Retinal fundus photograph, FOV: 45 degrees — 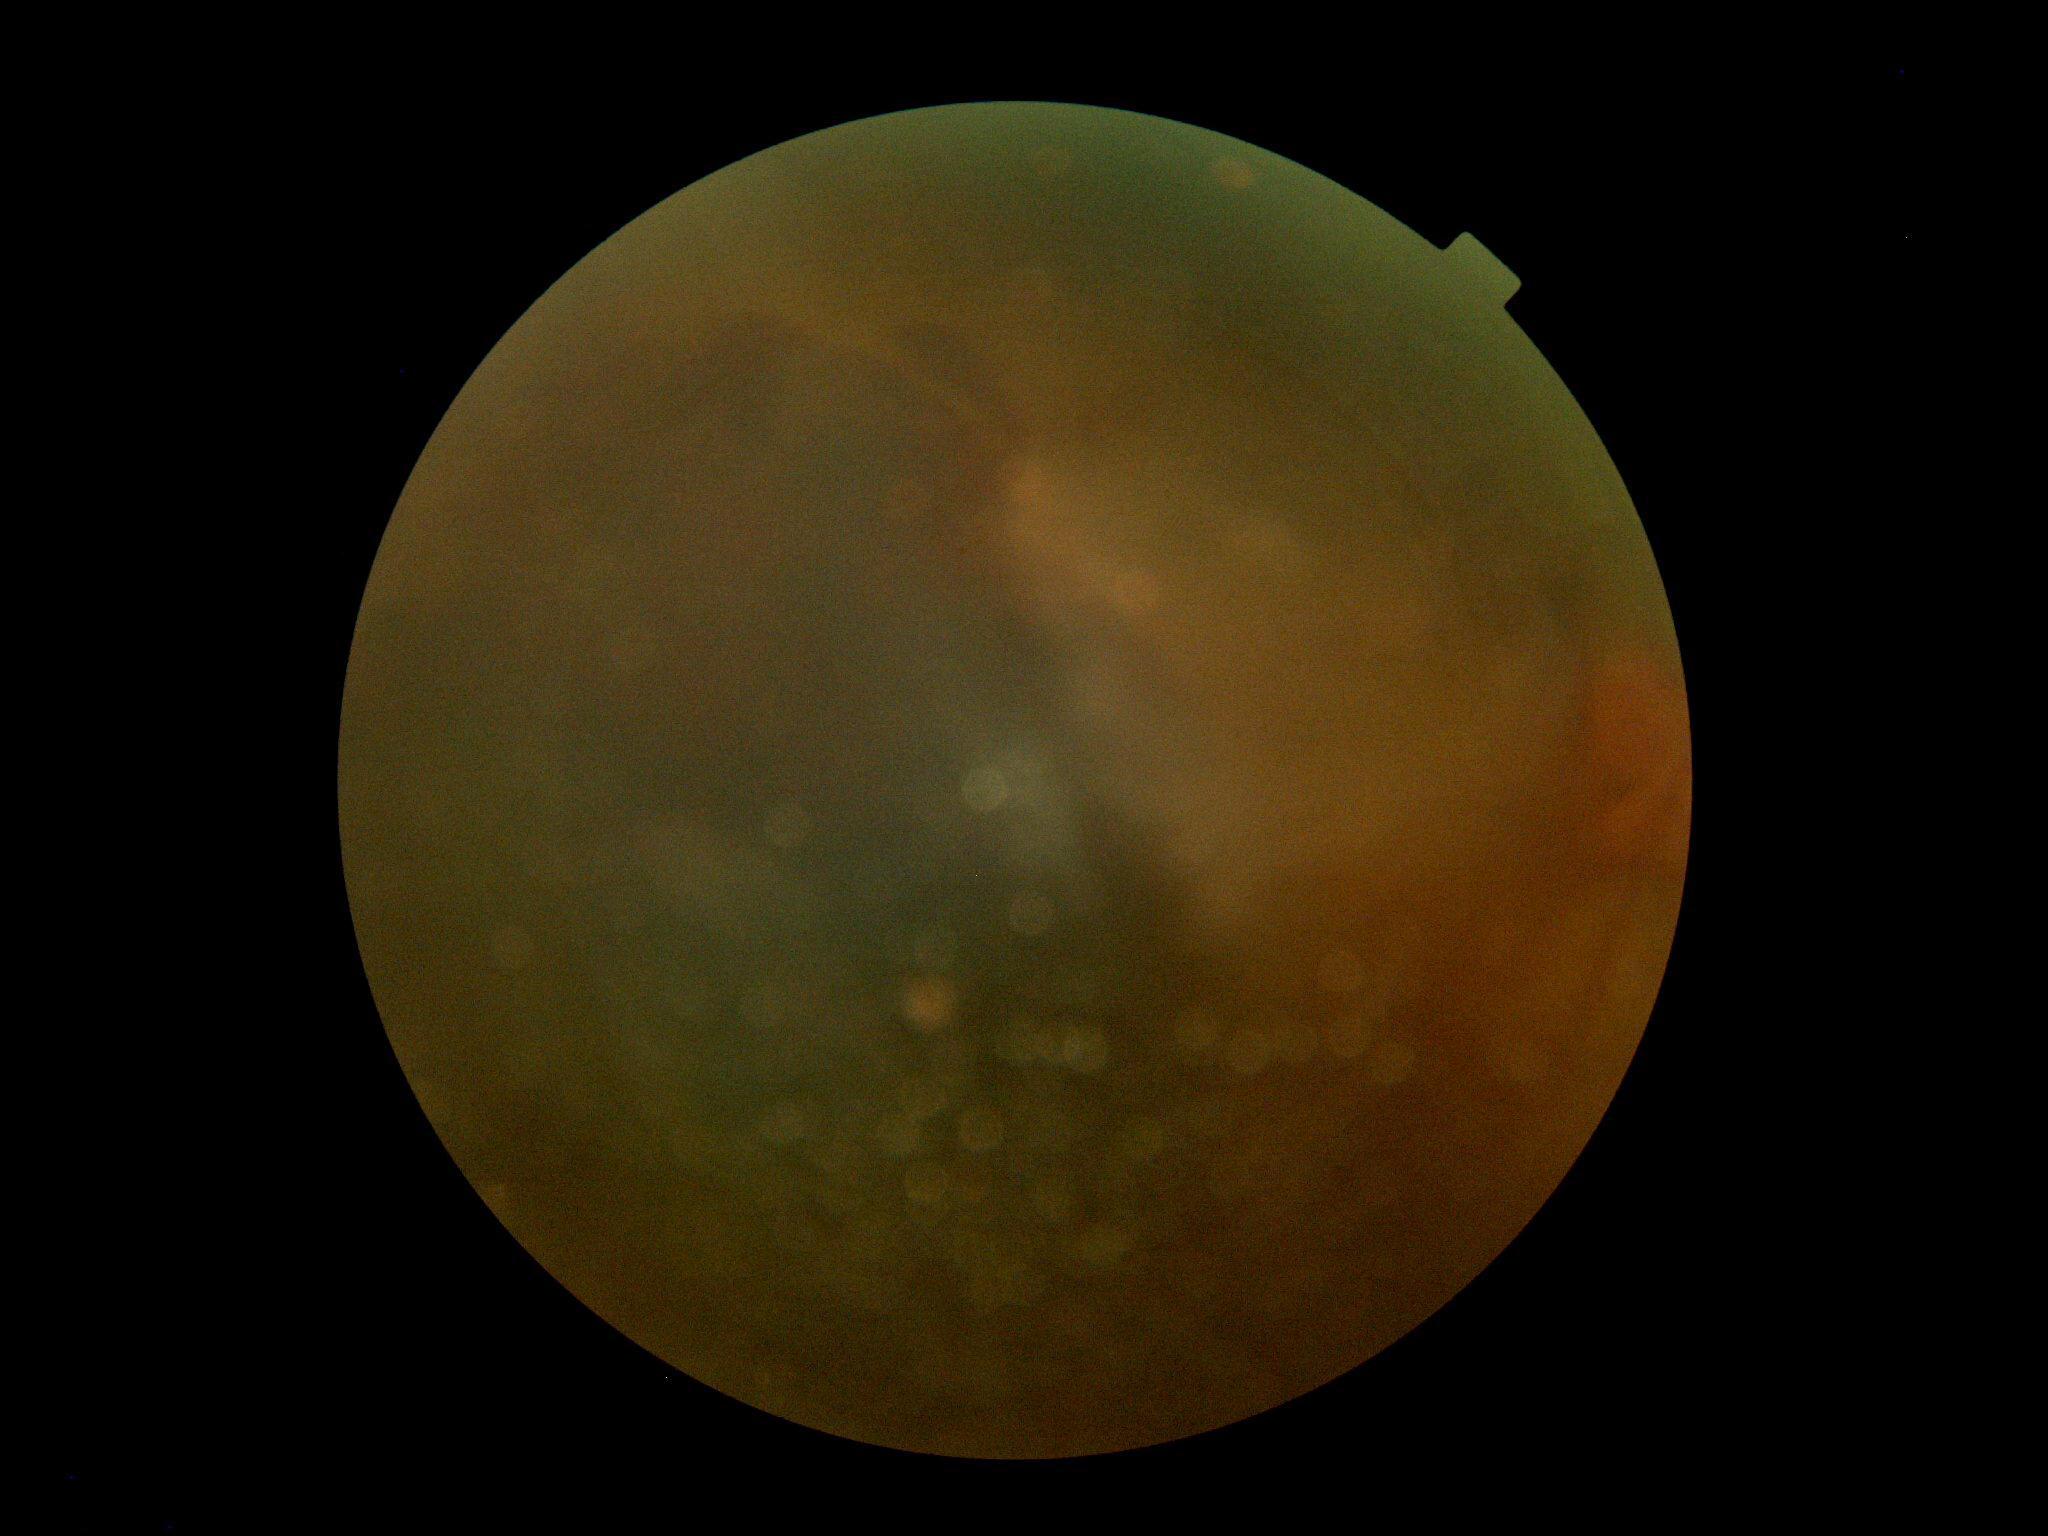
DR class: proliferative diabetic retinopathy, diabetic retinopathy (DR): PDR (grade 4).